Camera: Phoenix ICON (100° FOV). Wide-field fundus photograph from neonatal ROP screening: 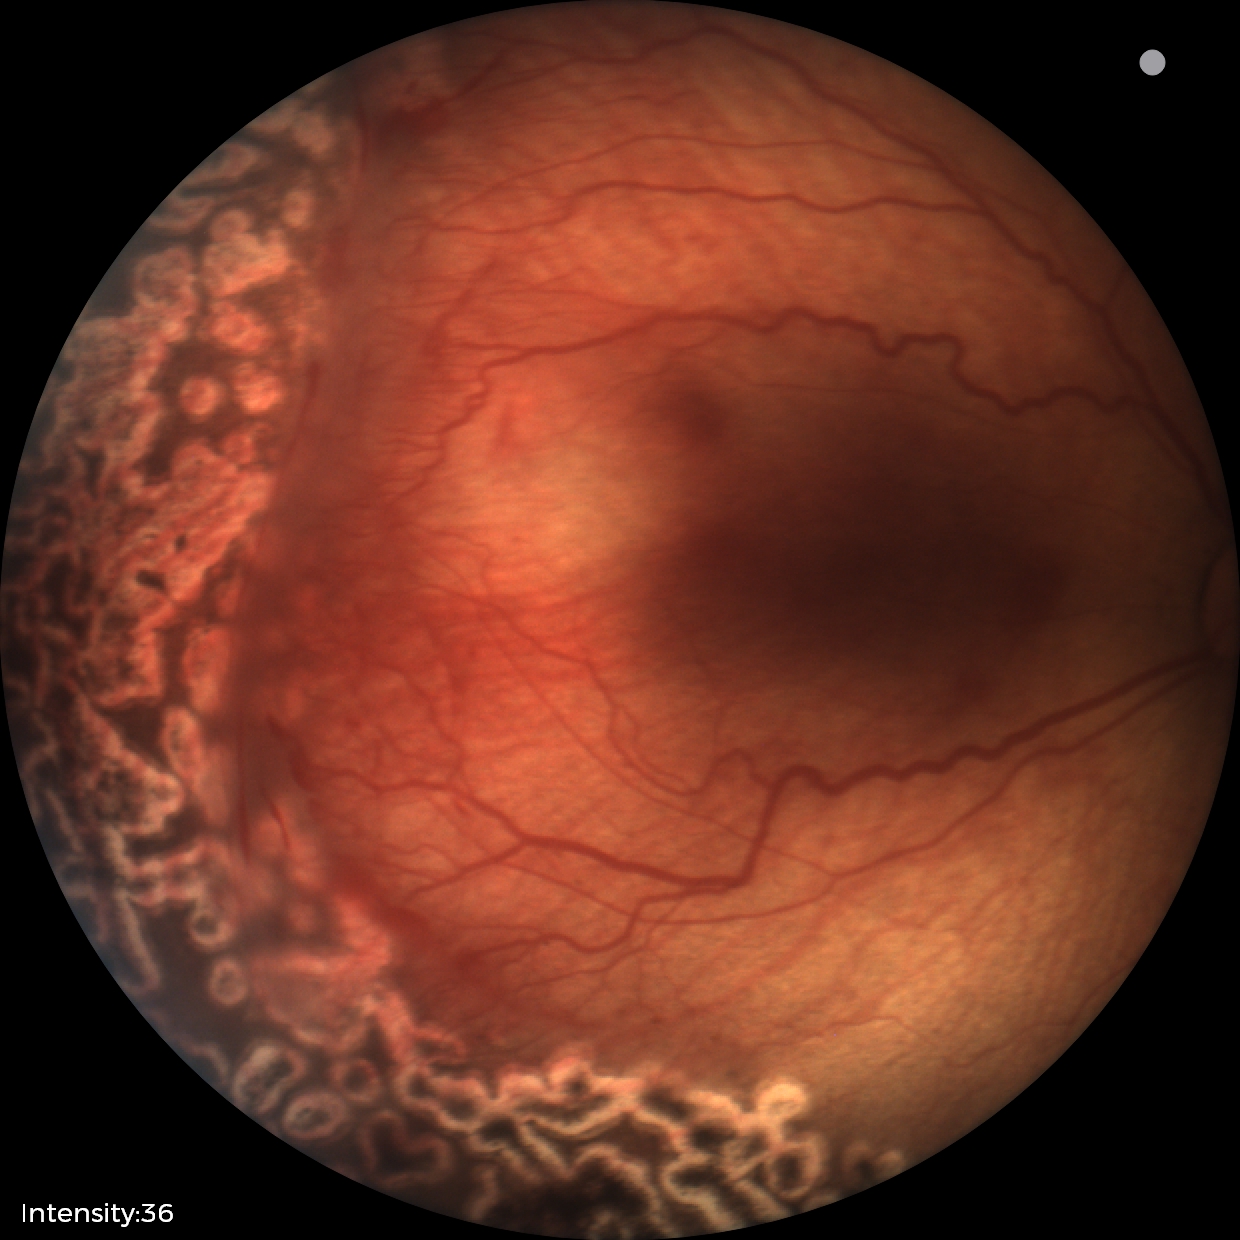

Assessment = status post ROP
plus disease = absent